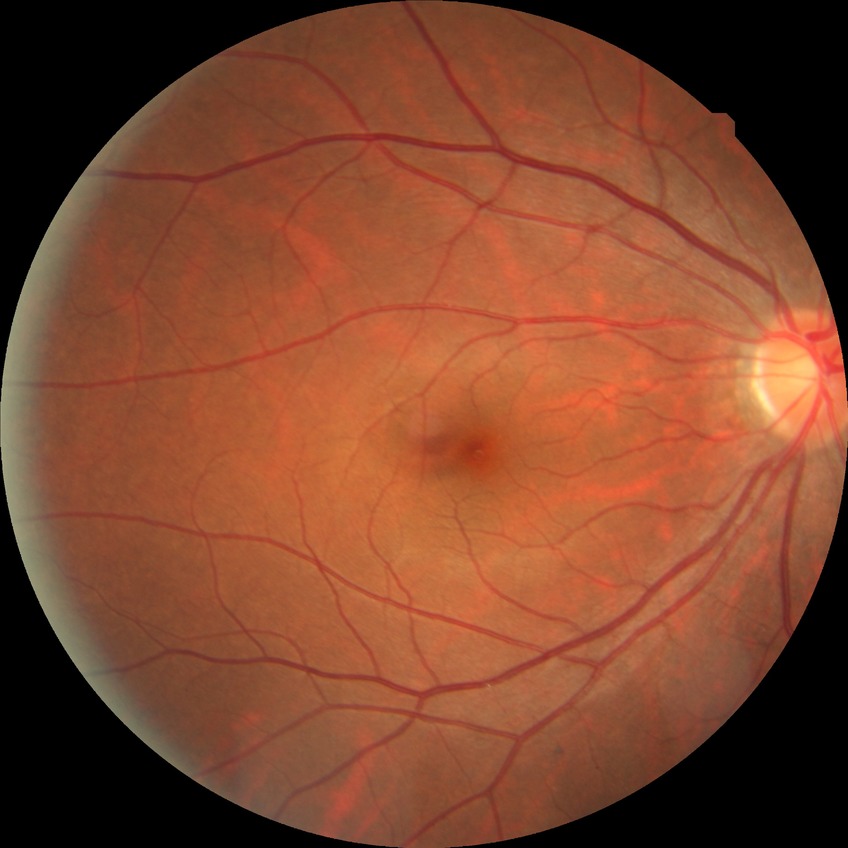 Diabetic retinopathy (DR): no diabetic retinopathy (NDR).